Wide-field fundus image from infant ROP screening.
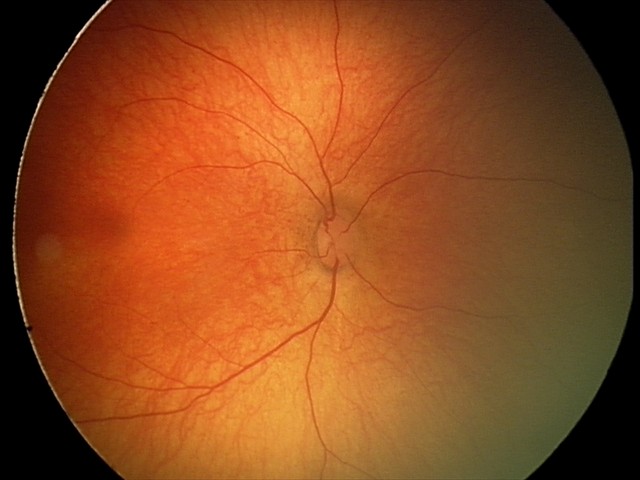

Screening examination with no abnormal retinal findings.